Color fundus image:
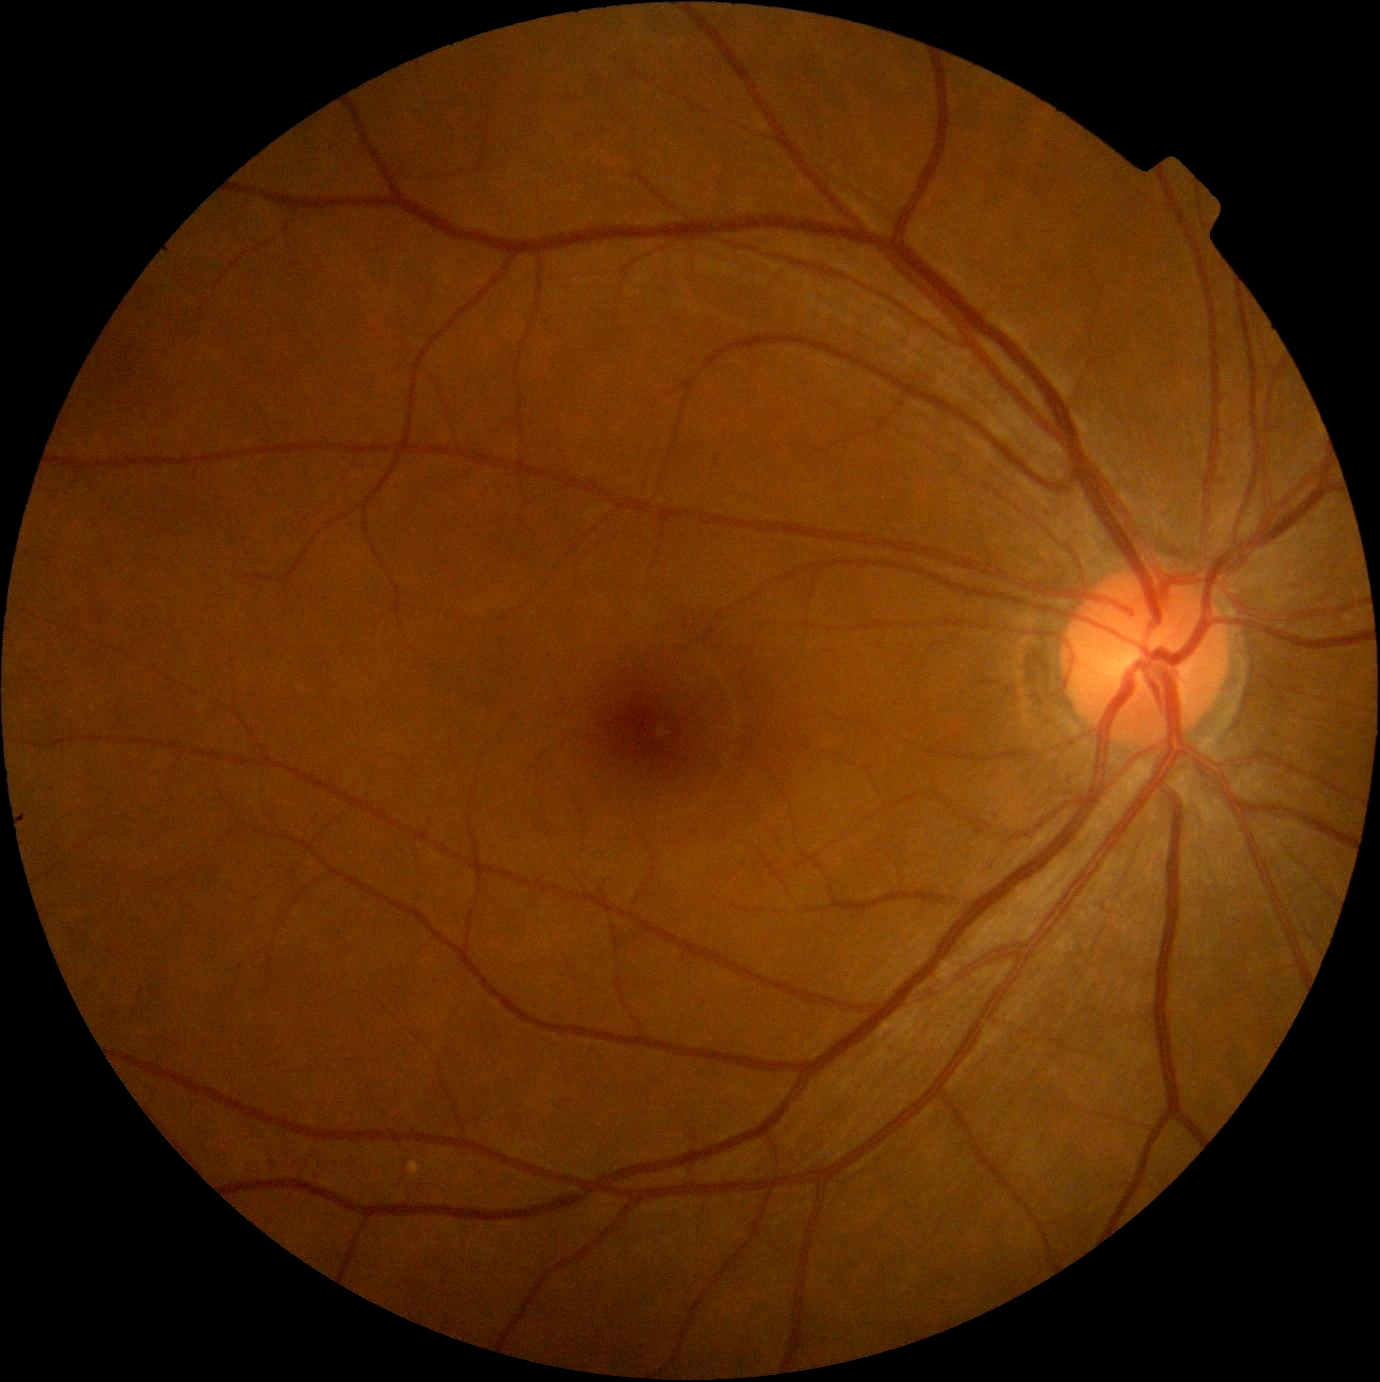
Findings:
– DR severity: no apparent retinopathy (grade 0)